Diabetic retinopathy graded by the modified Davis classification: 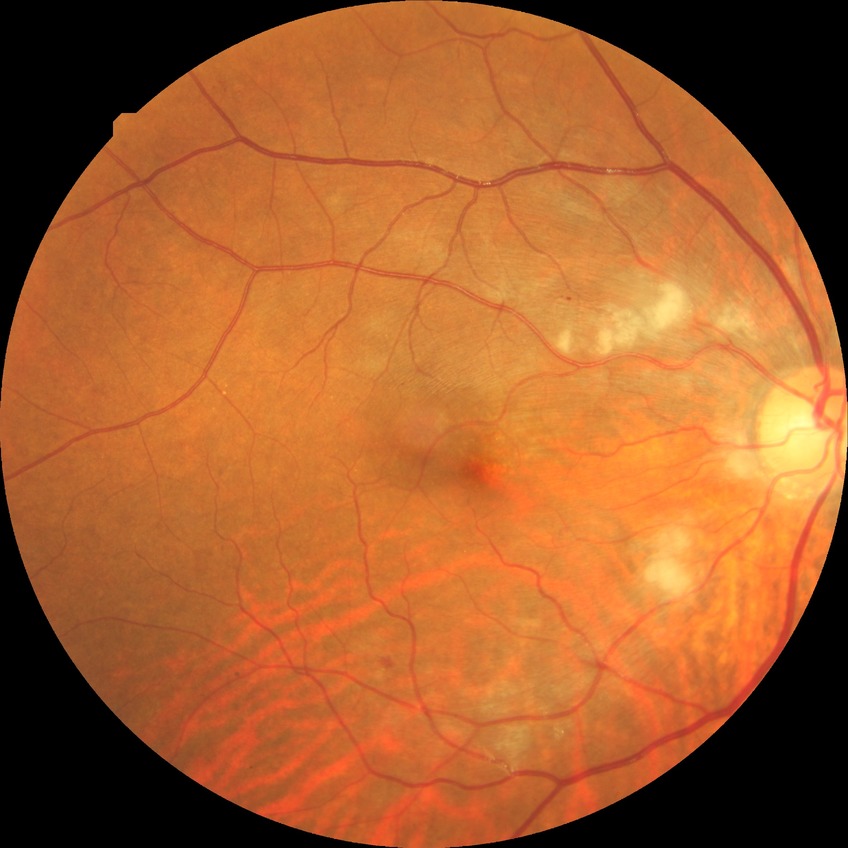
Diabetic retinopathy stage: pre-proliferative diabetic retinopathy.